Portable fundus photograph
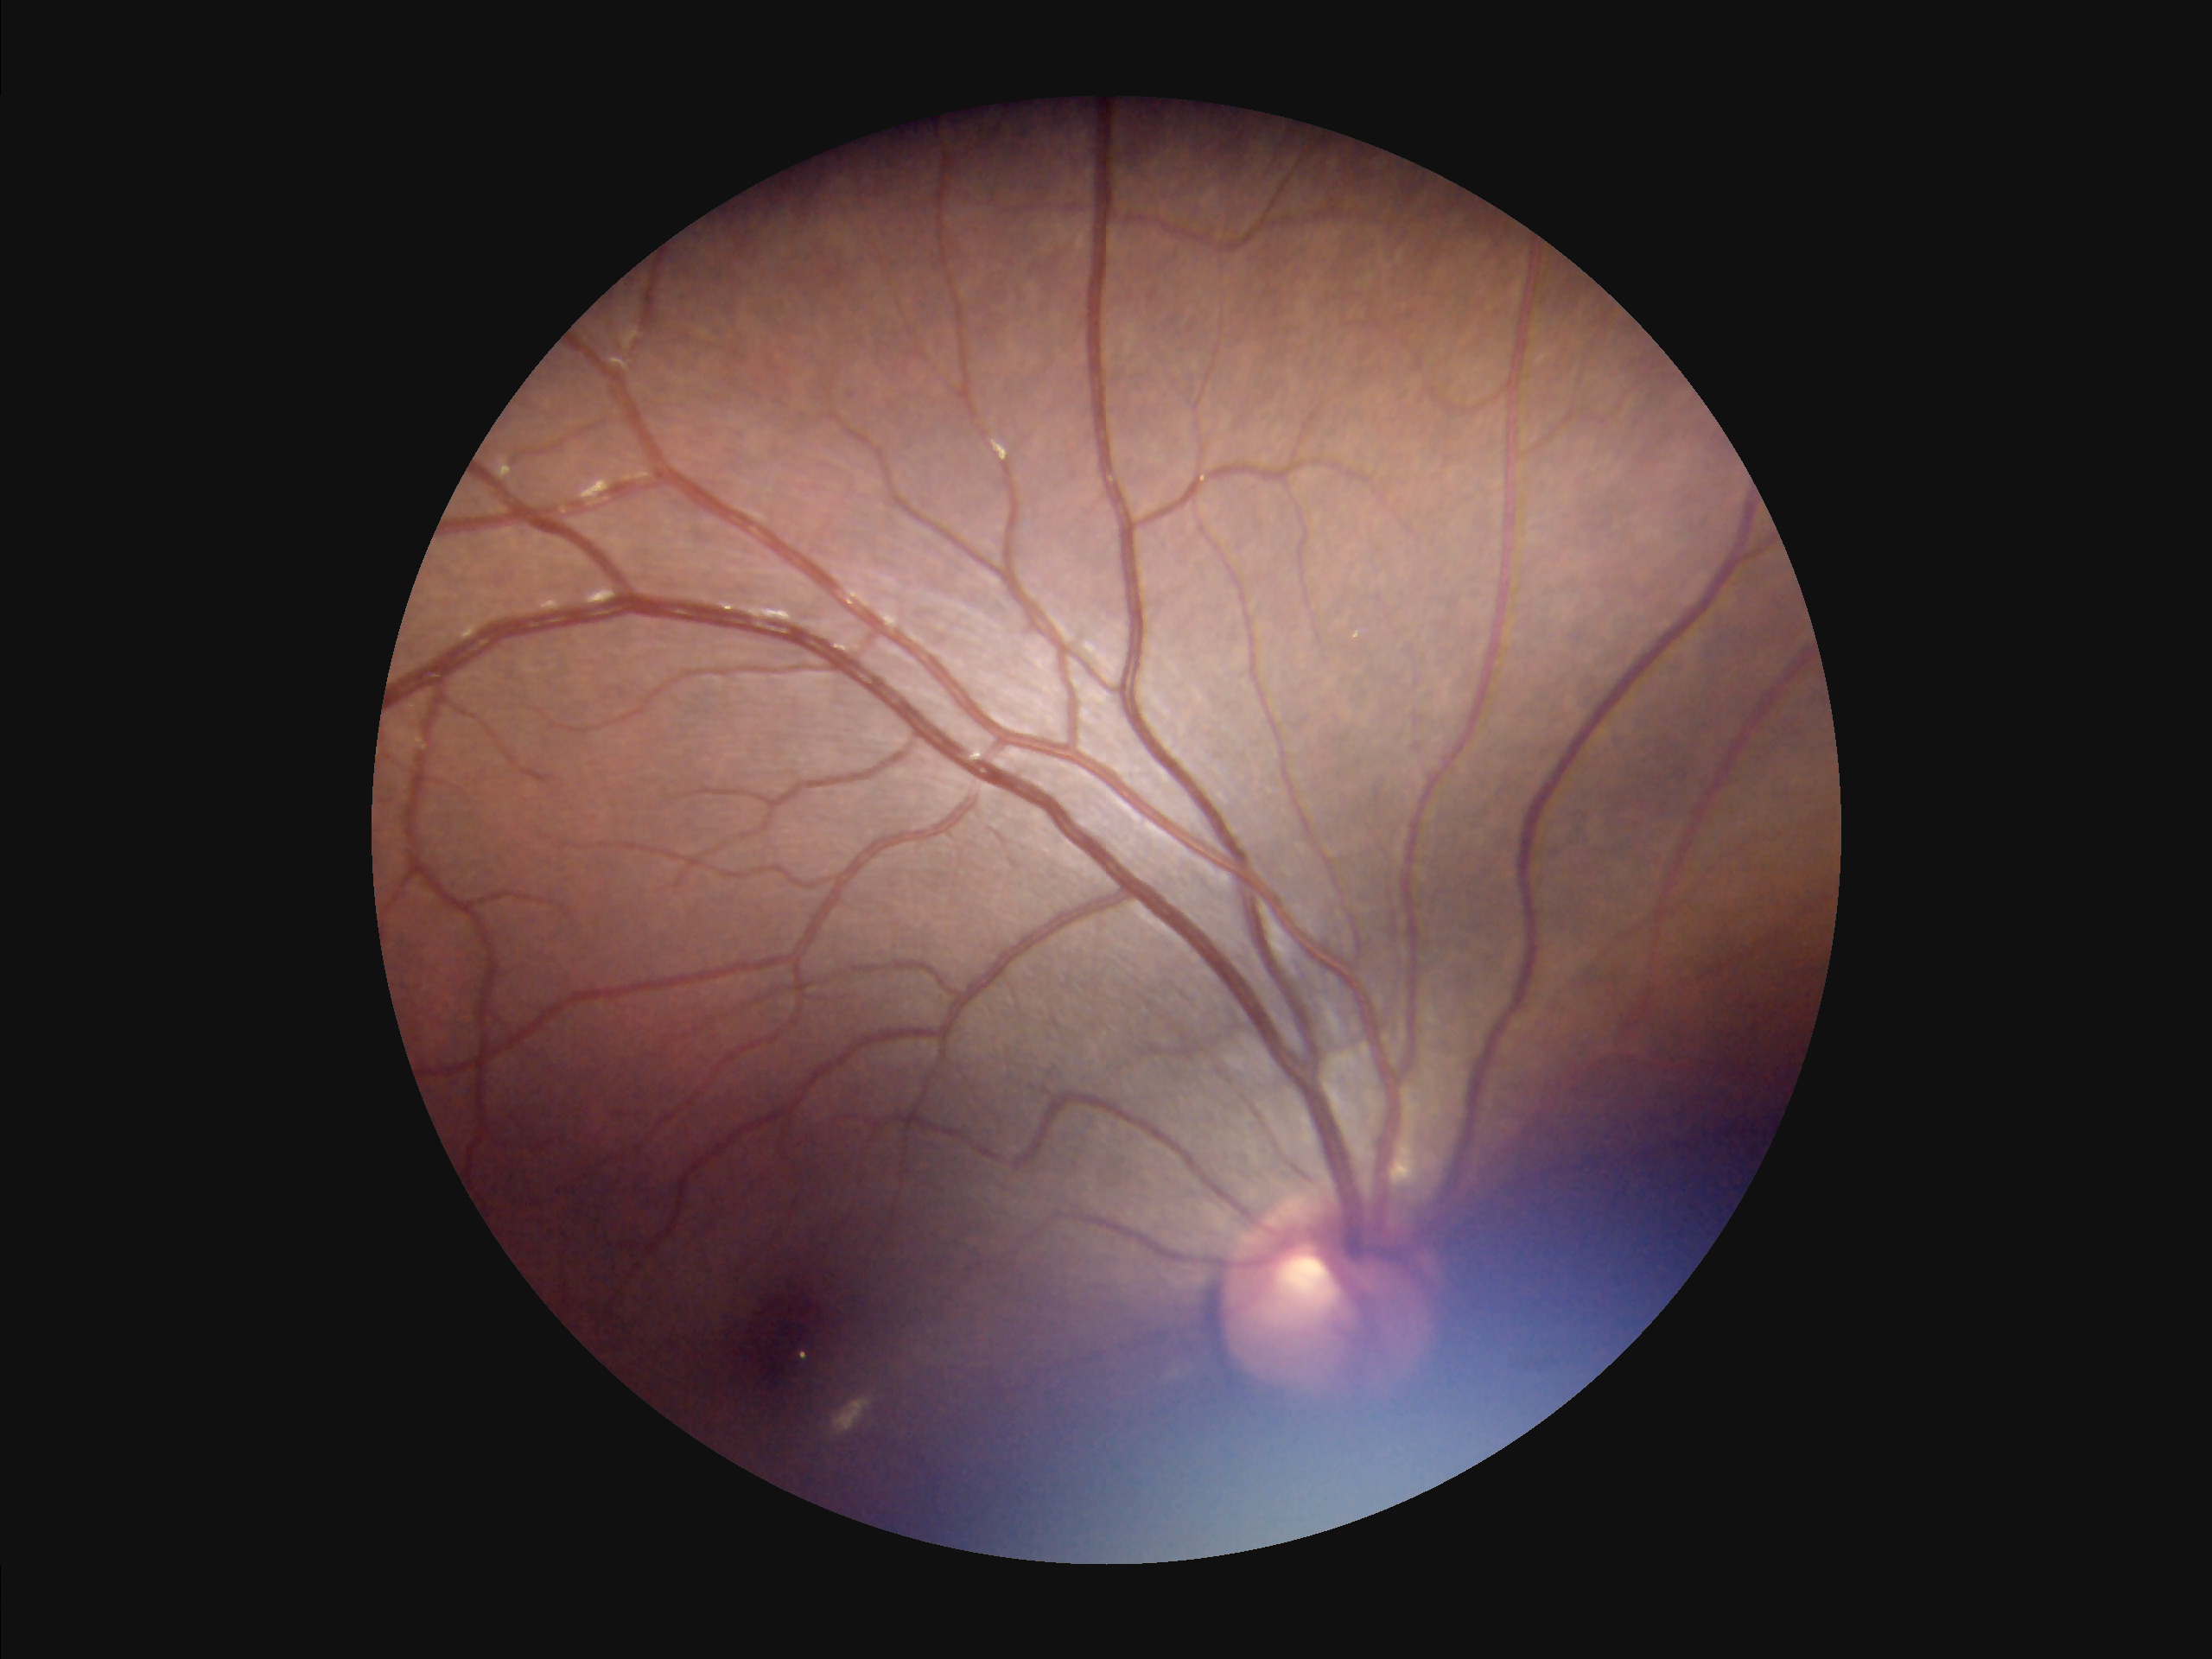 Overall quality is poor; the image is difficult to grade. No noticeable blur. Illumination and color are suboptimal.